Color fundus photograph; 2048x1536.
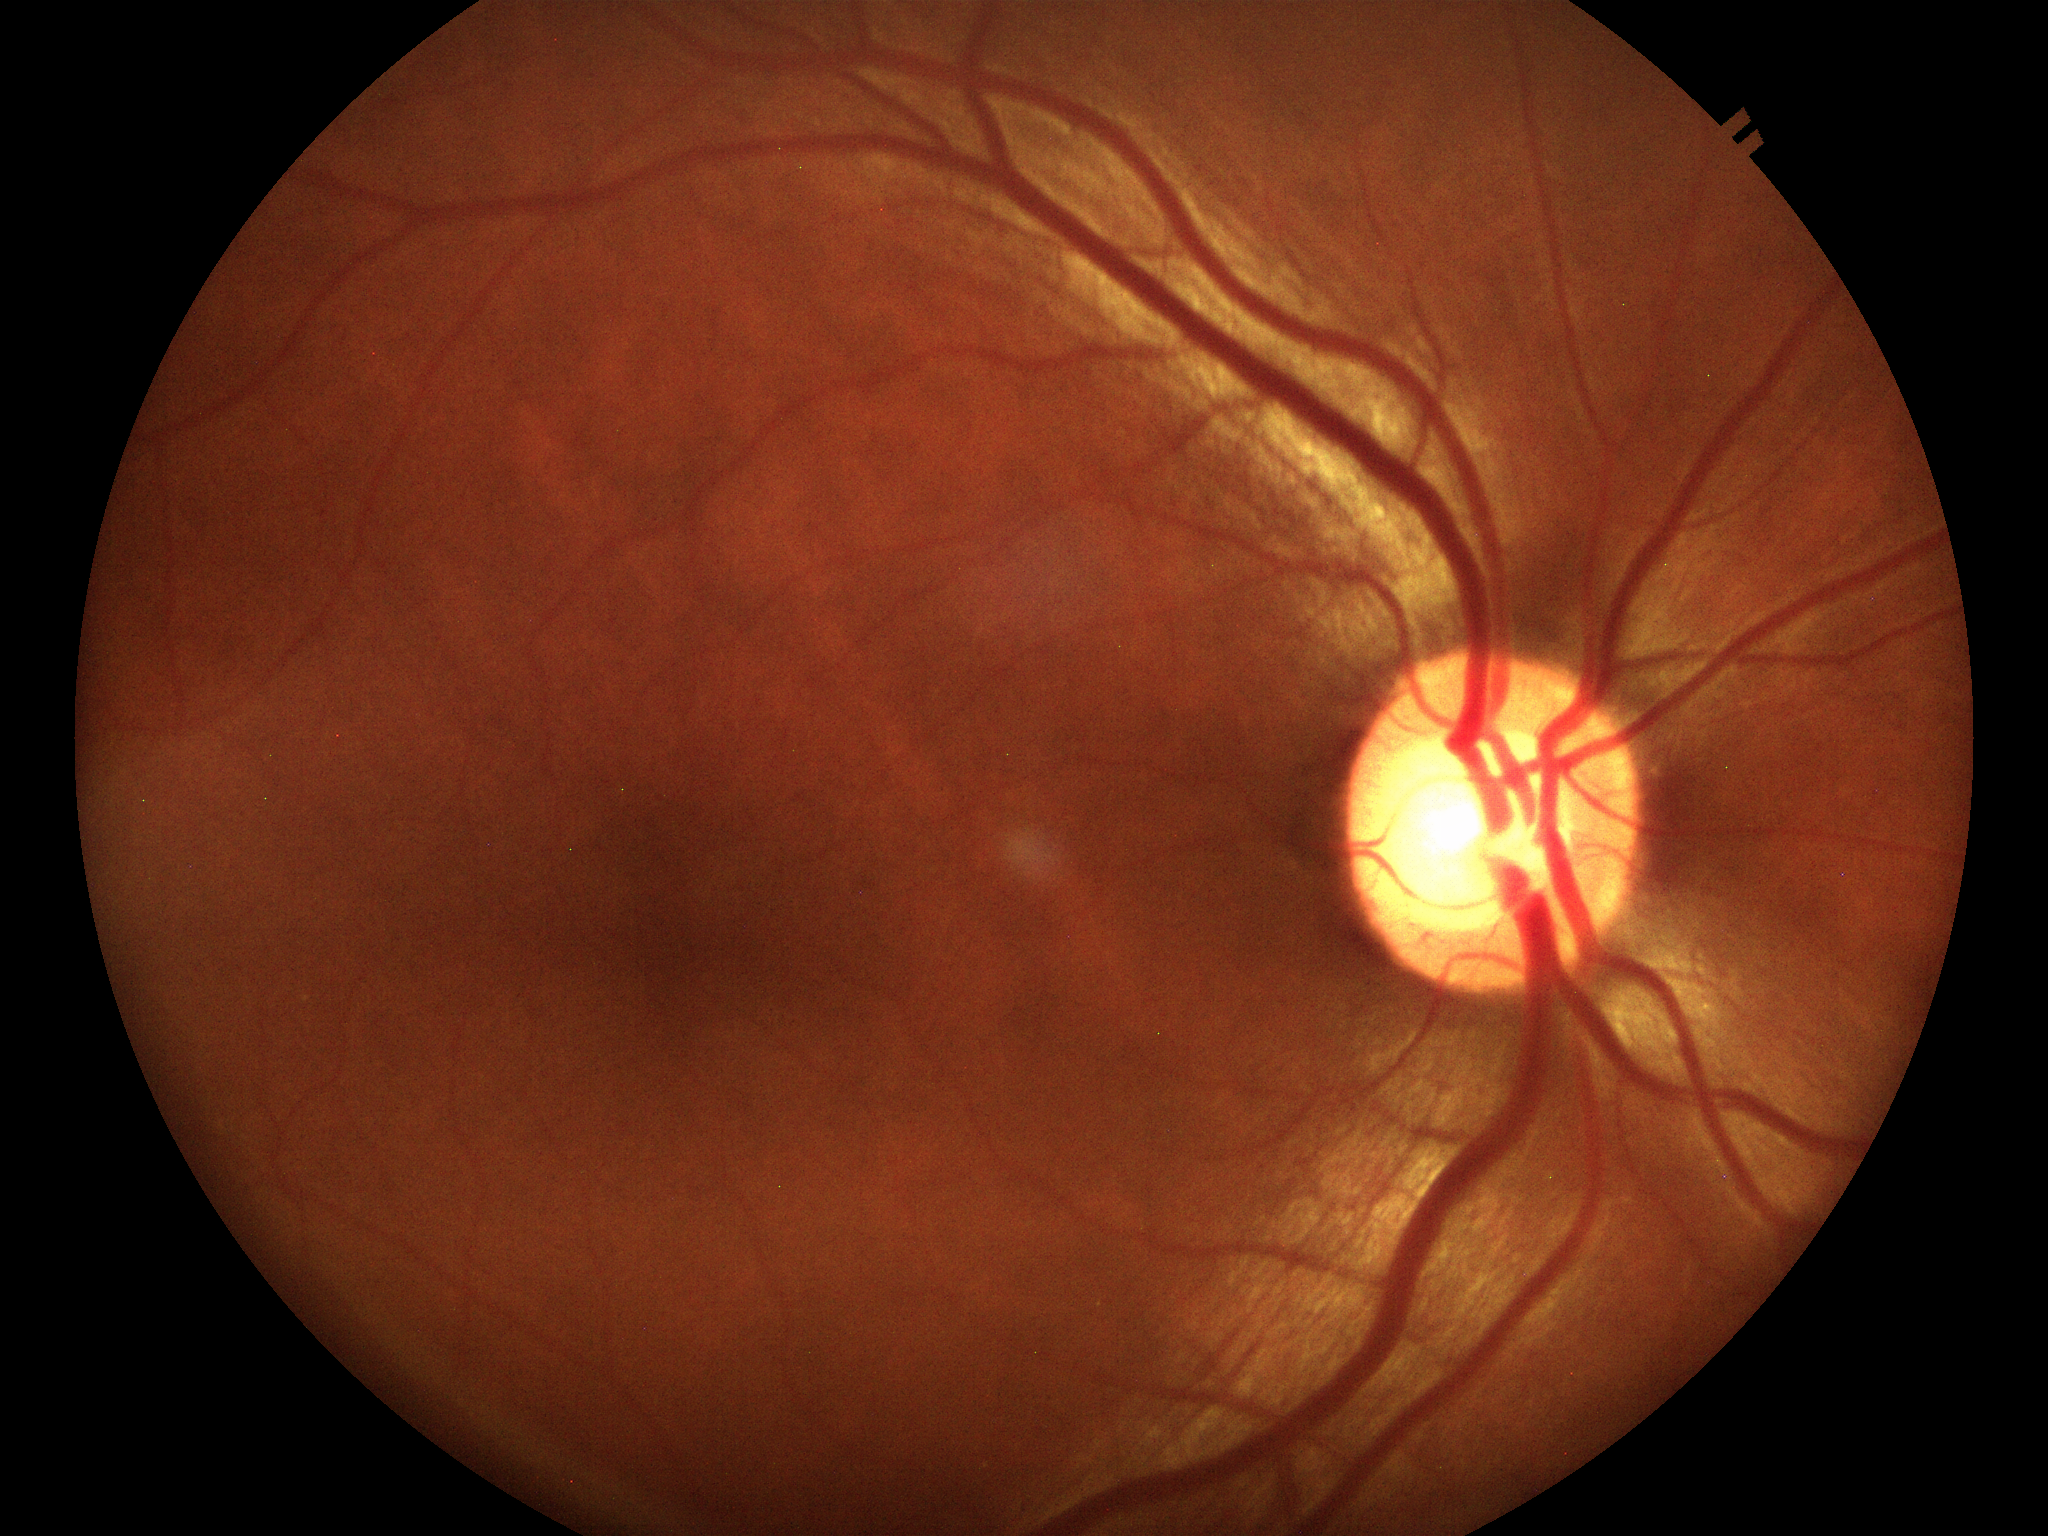 Vertical C/D ratio (VCDR): 0.66.
Suspect for glaucomatous optic neuropathy.